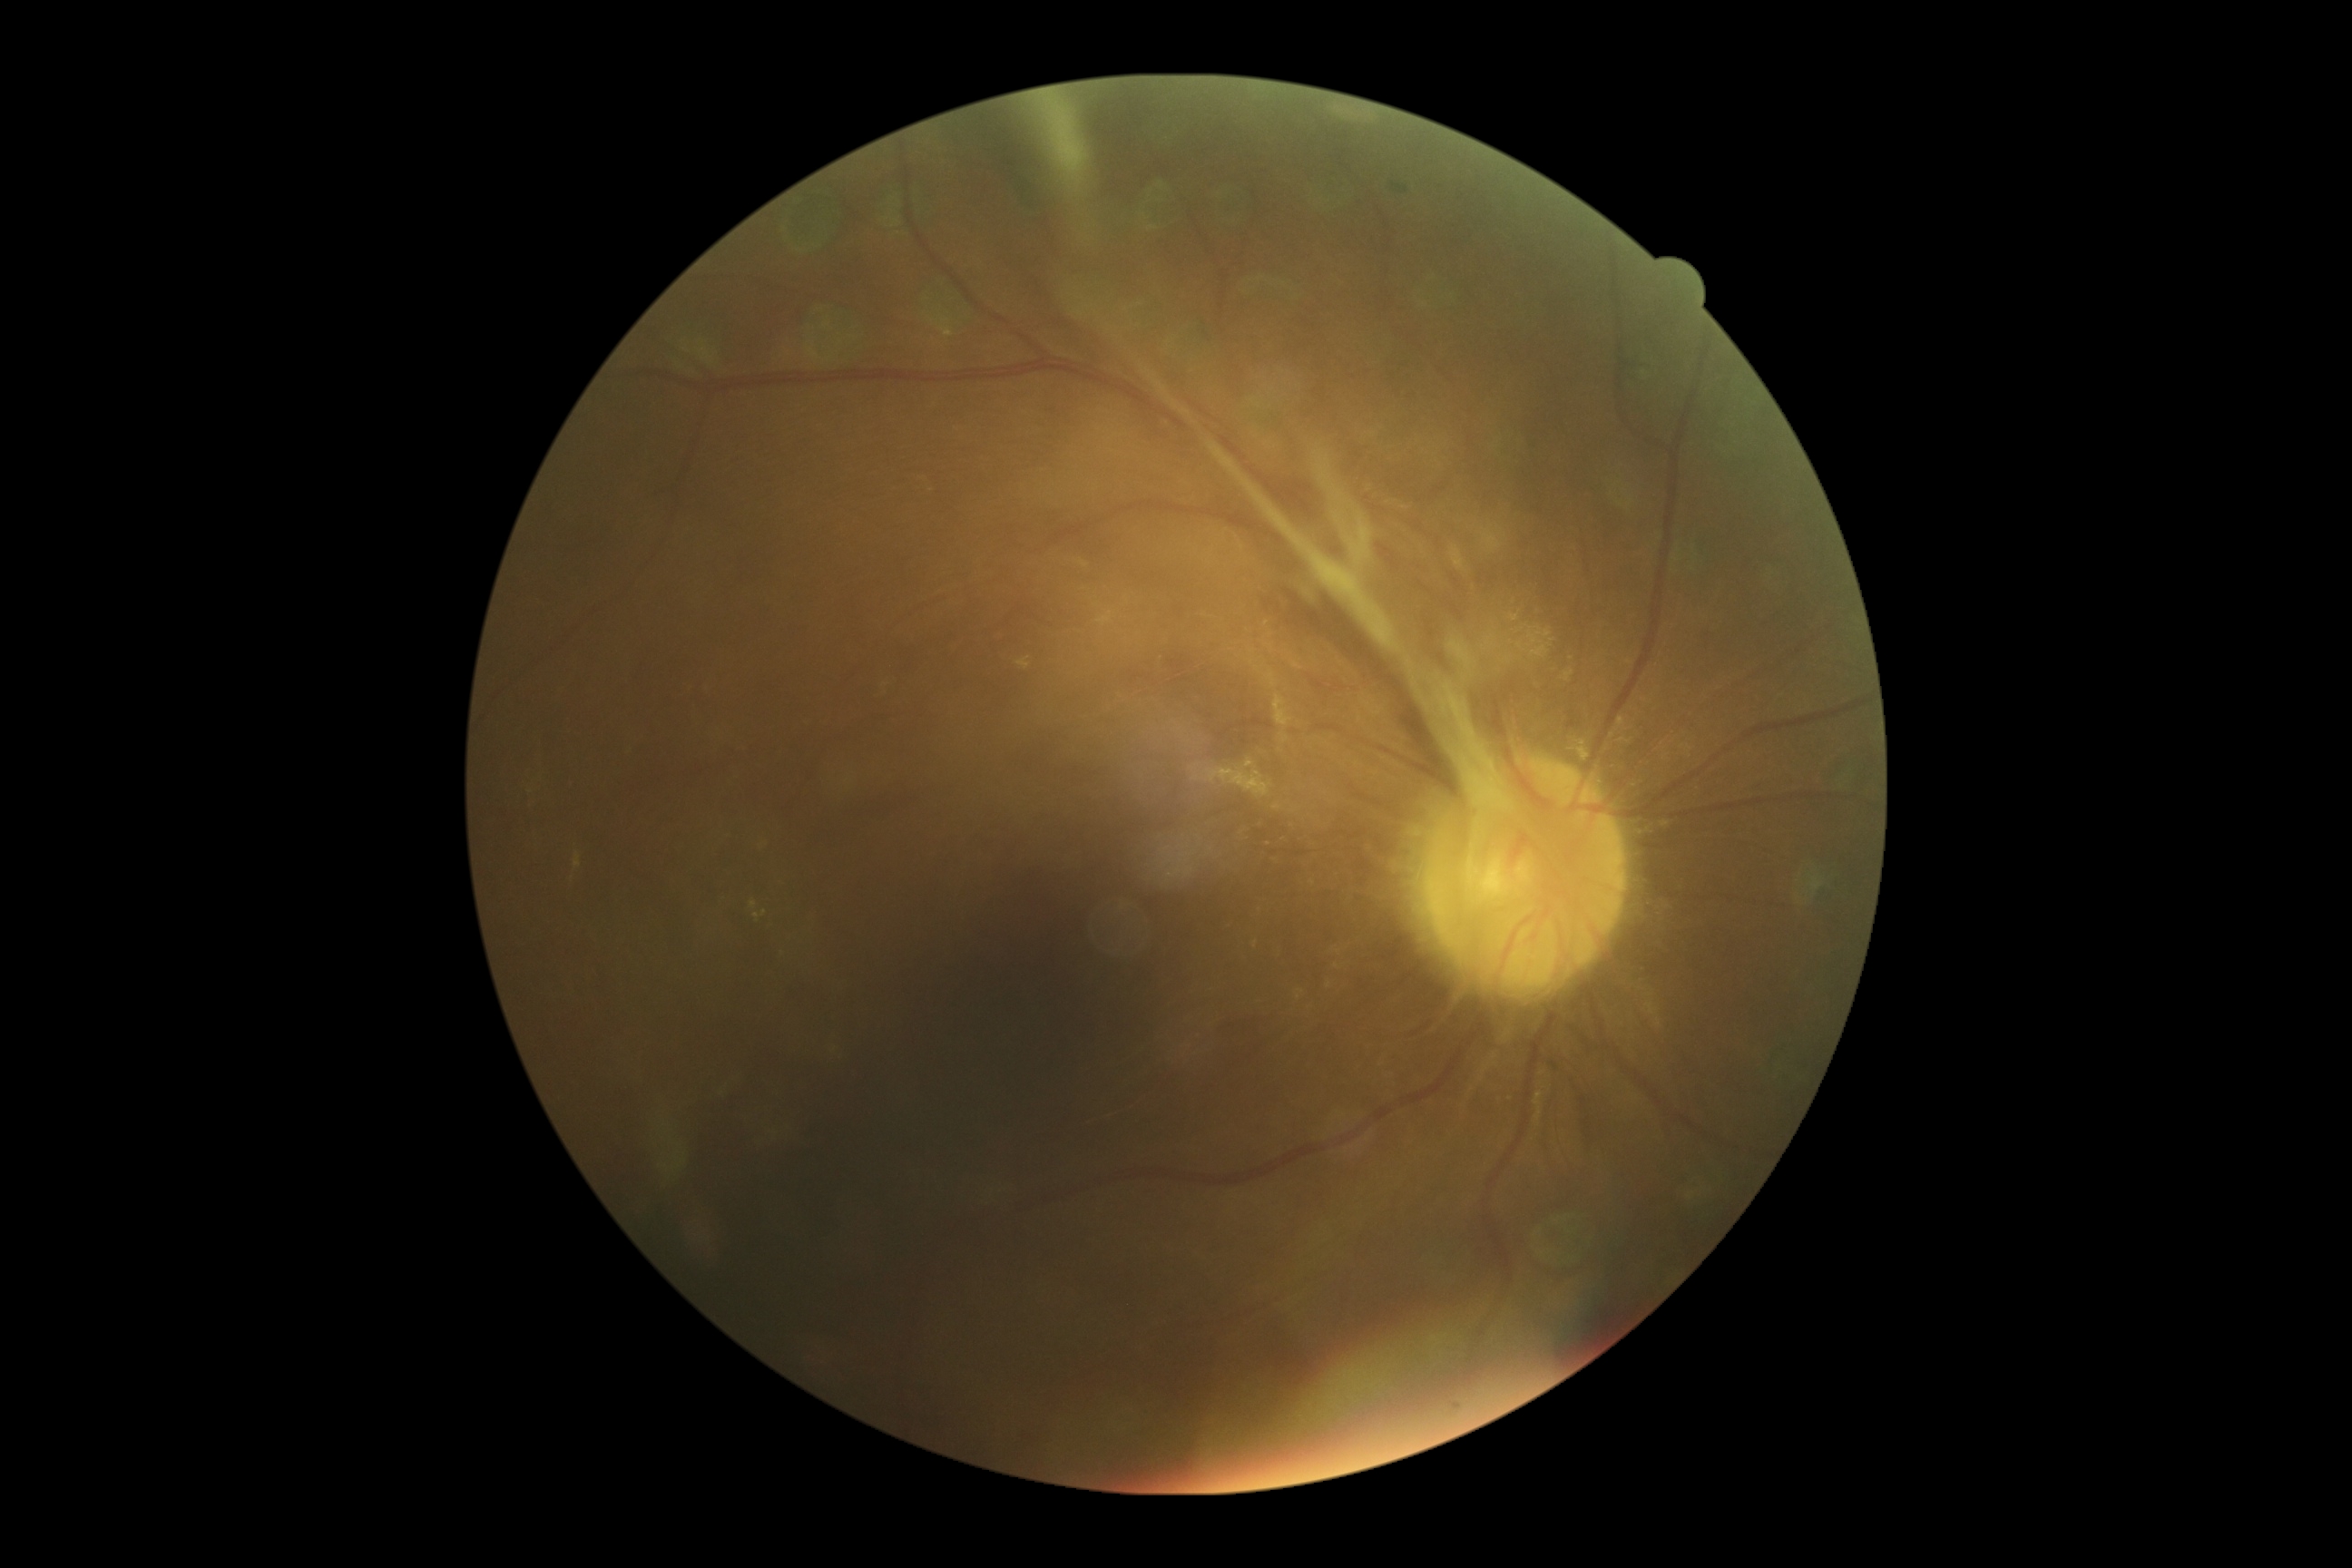   dr_grade: 4/4